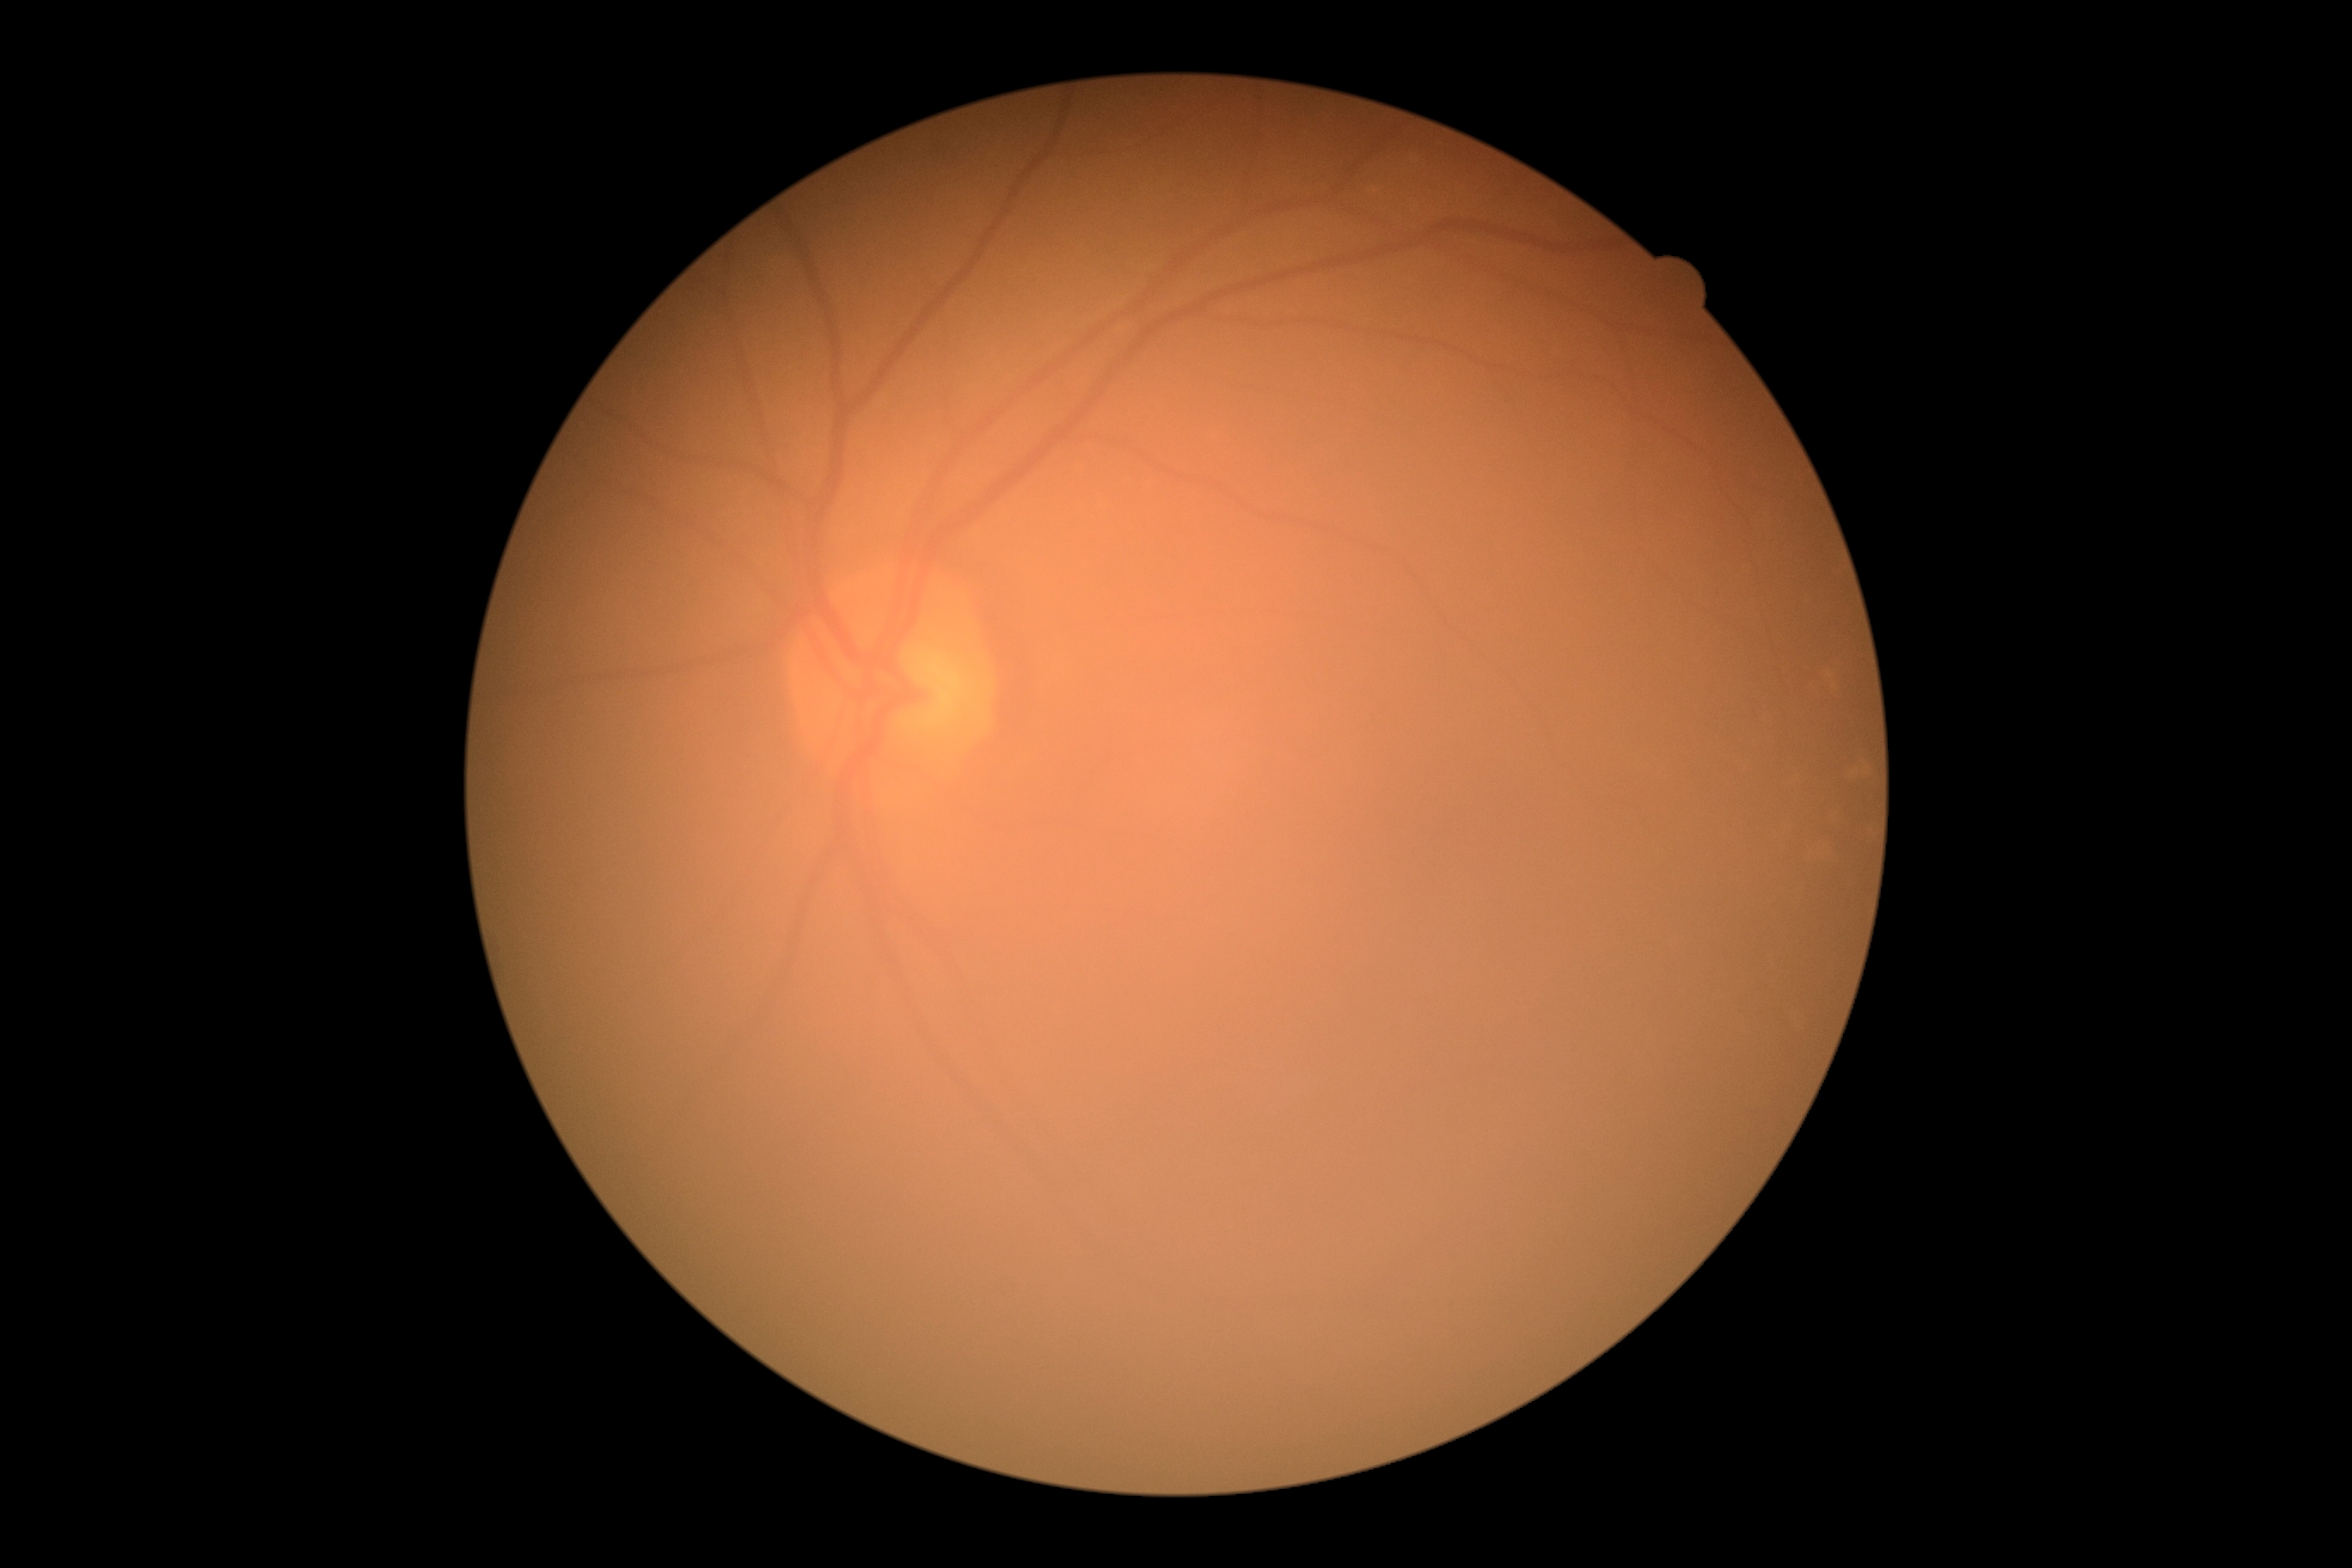

No diabetic retinal disease findings. DR grade: 0 (no apparent retinopathy).